Image size 848x848, CFP.
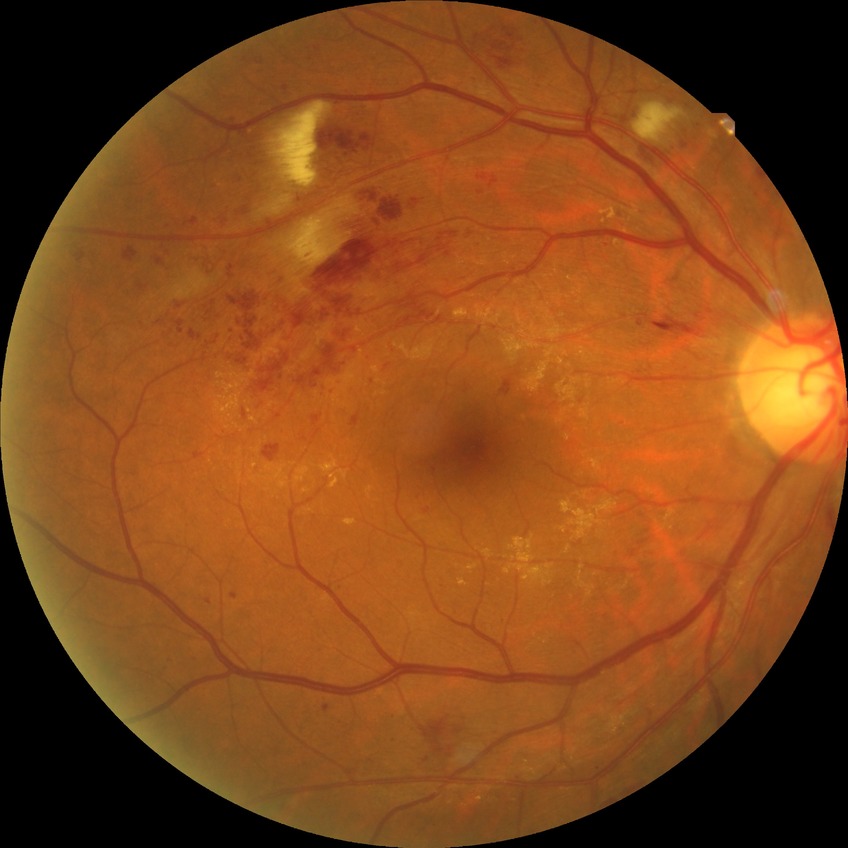 Davis grading is pre-proliferative diabetic retinopathy.